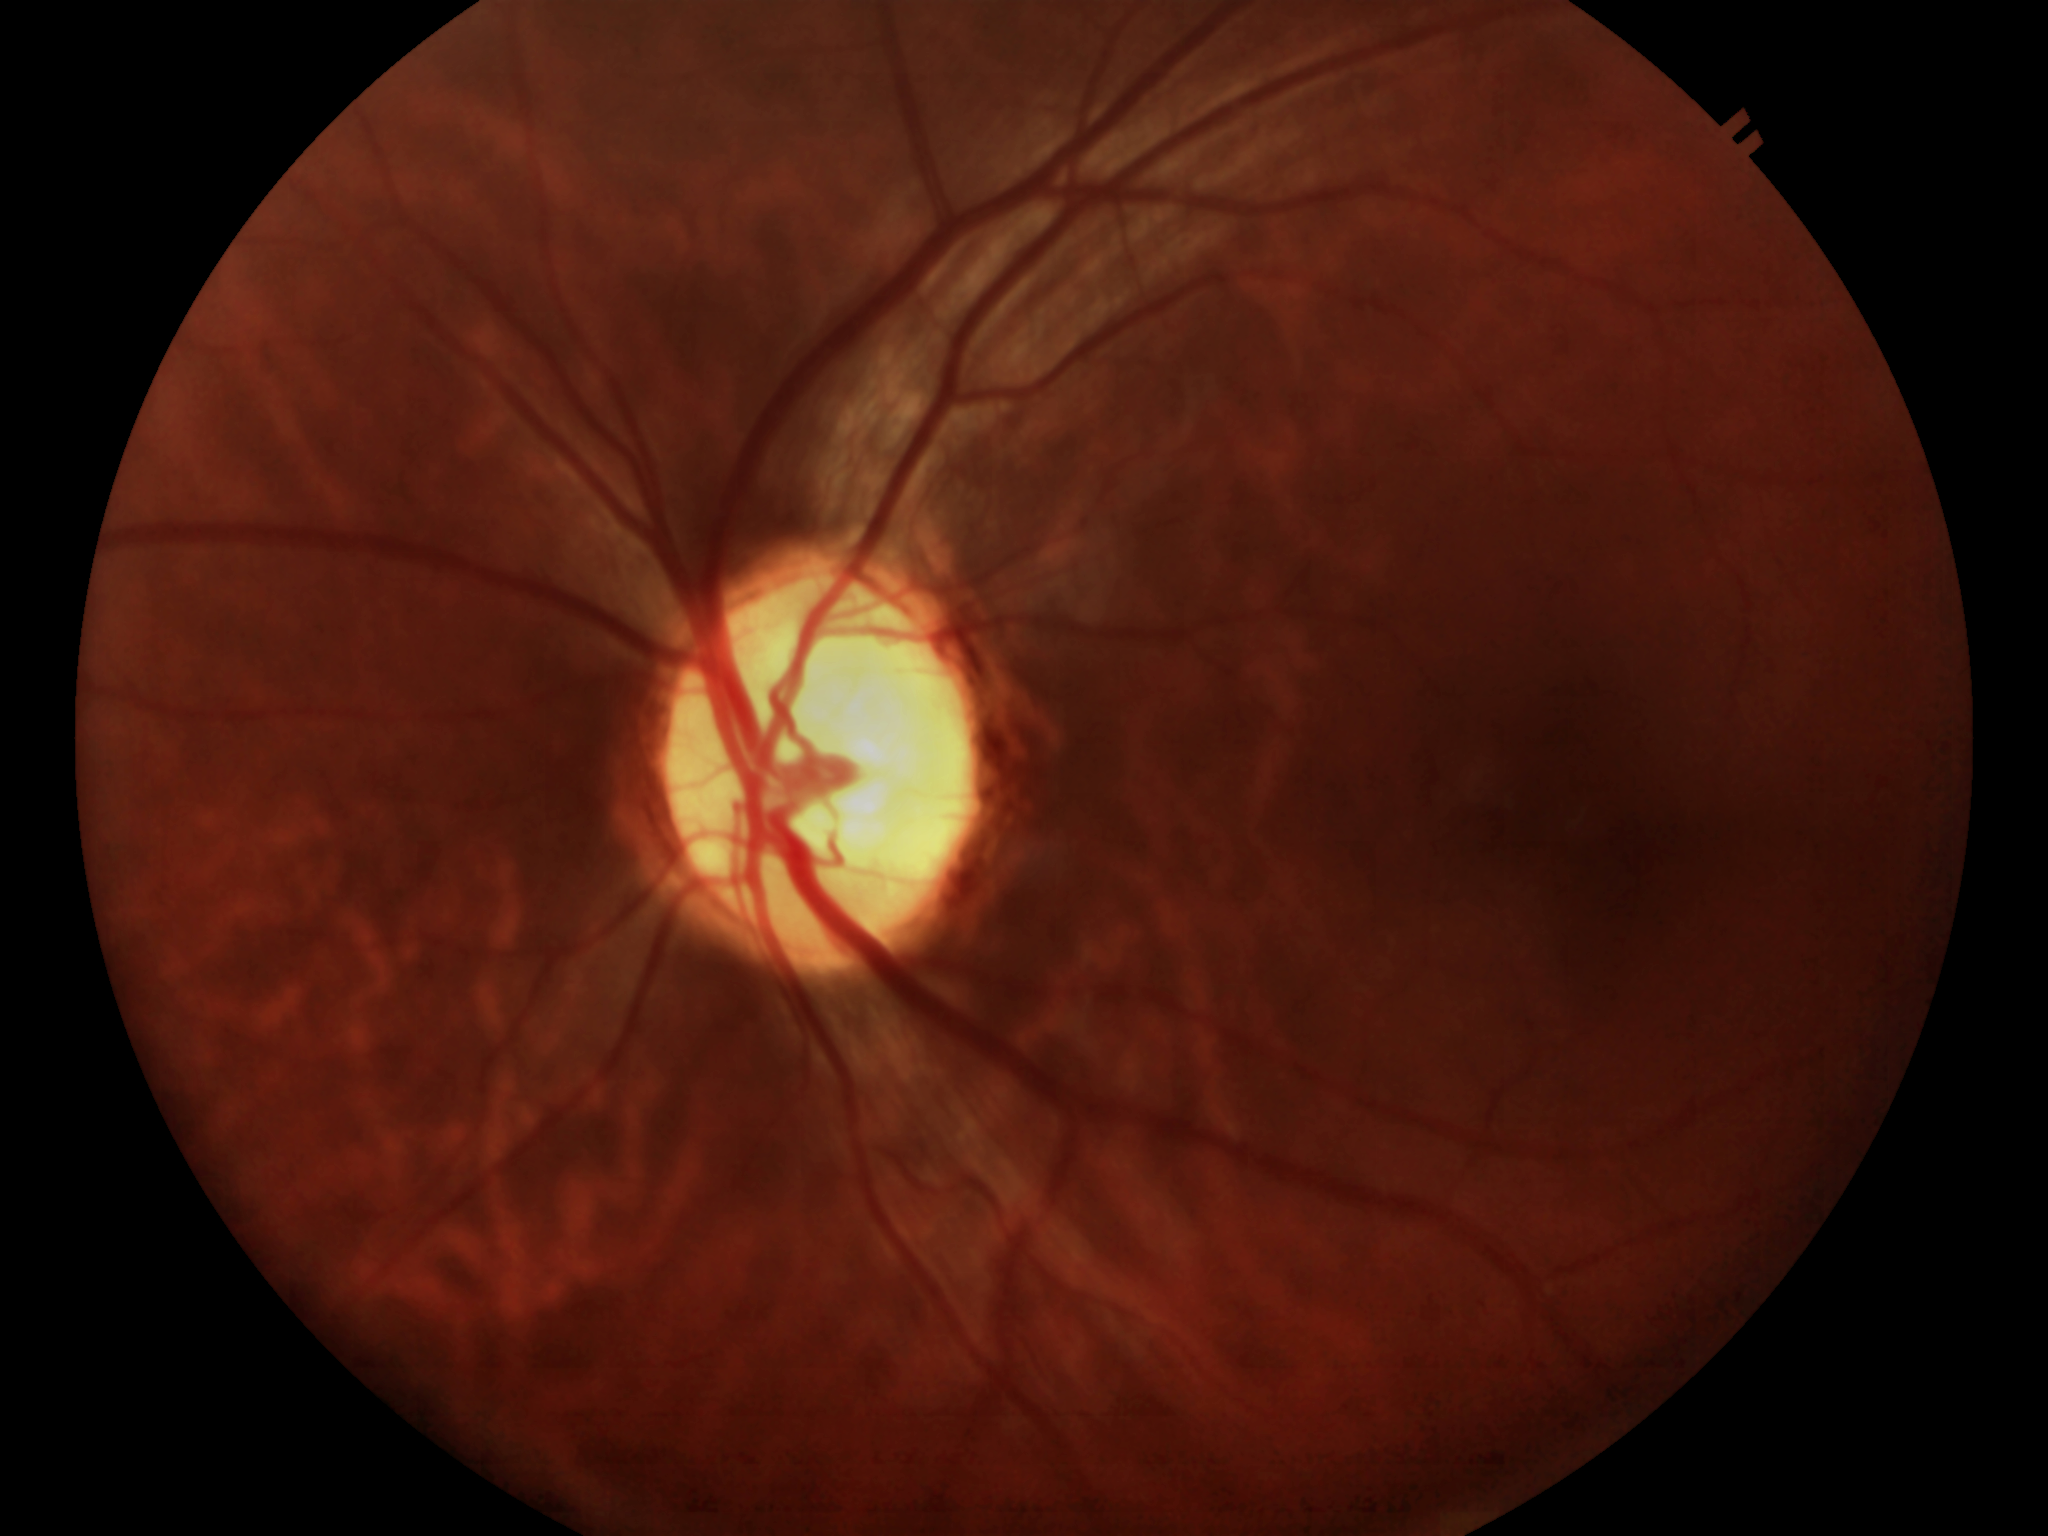 Area C/D ratio: 0.41. Concerning for glaucoma. Vertical cup-to-disc ratio: 0.67.